1932 x 1932 pixels: 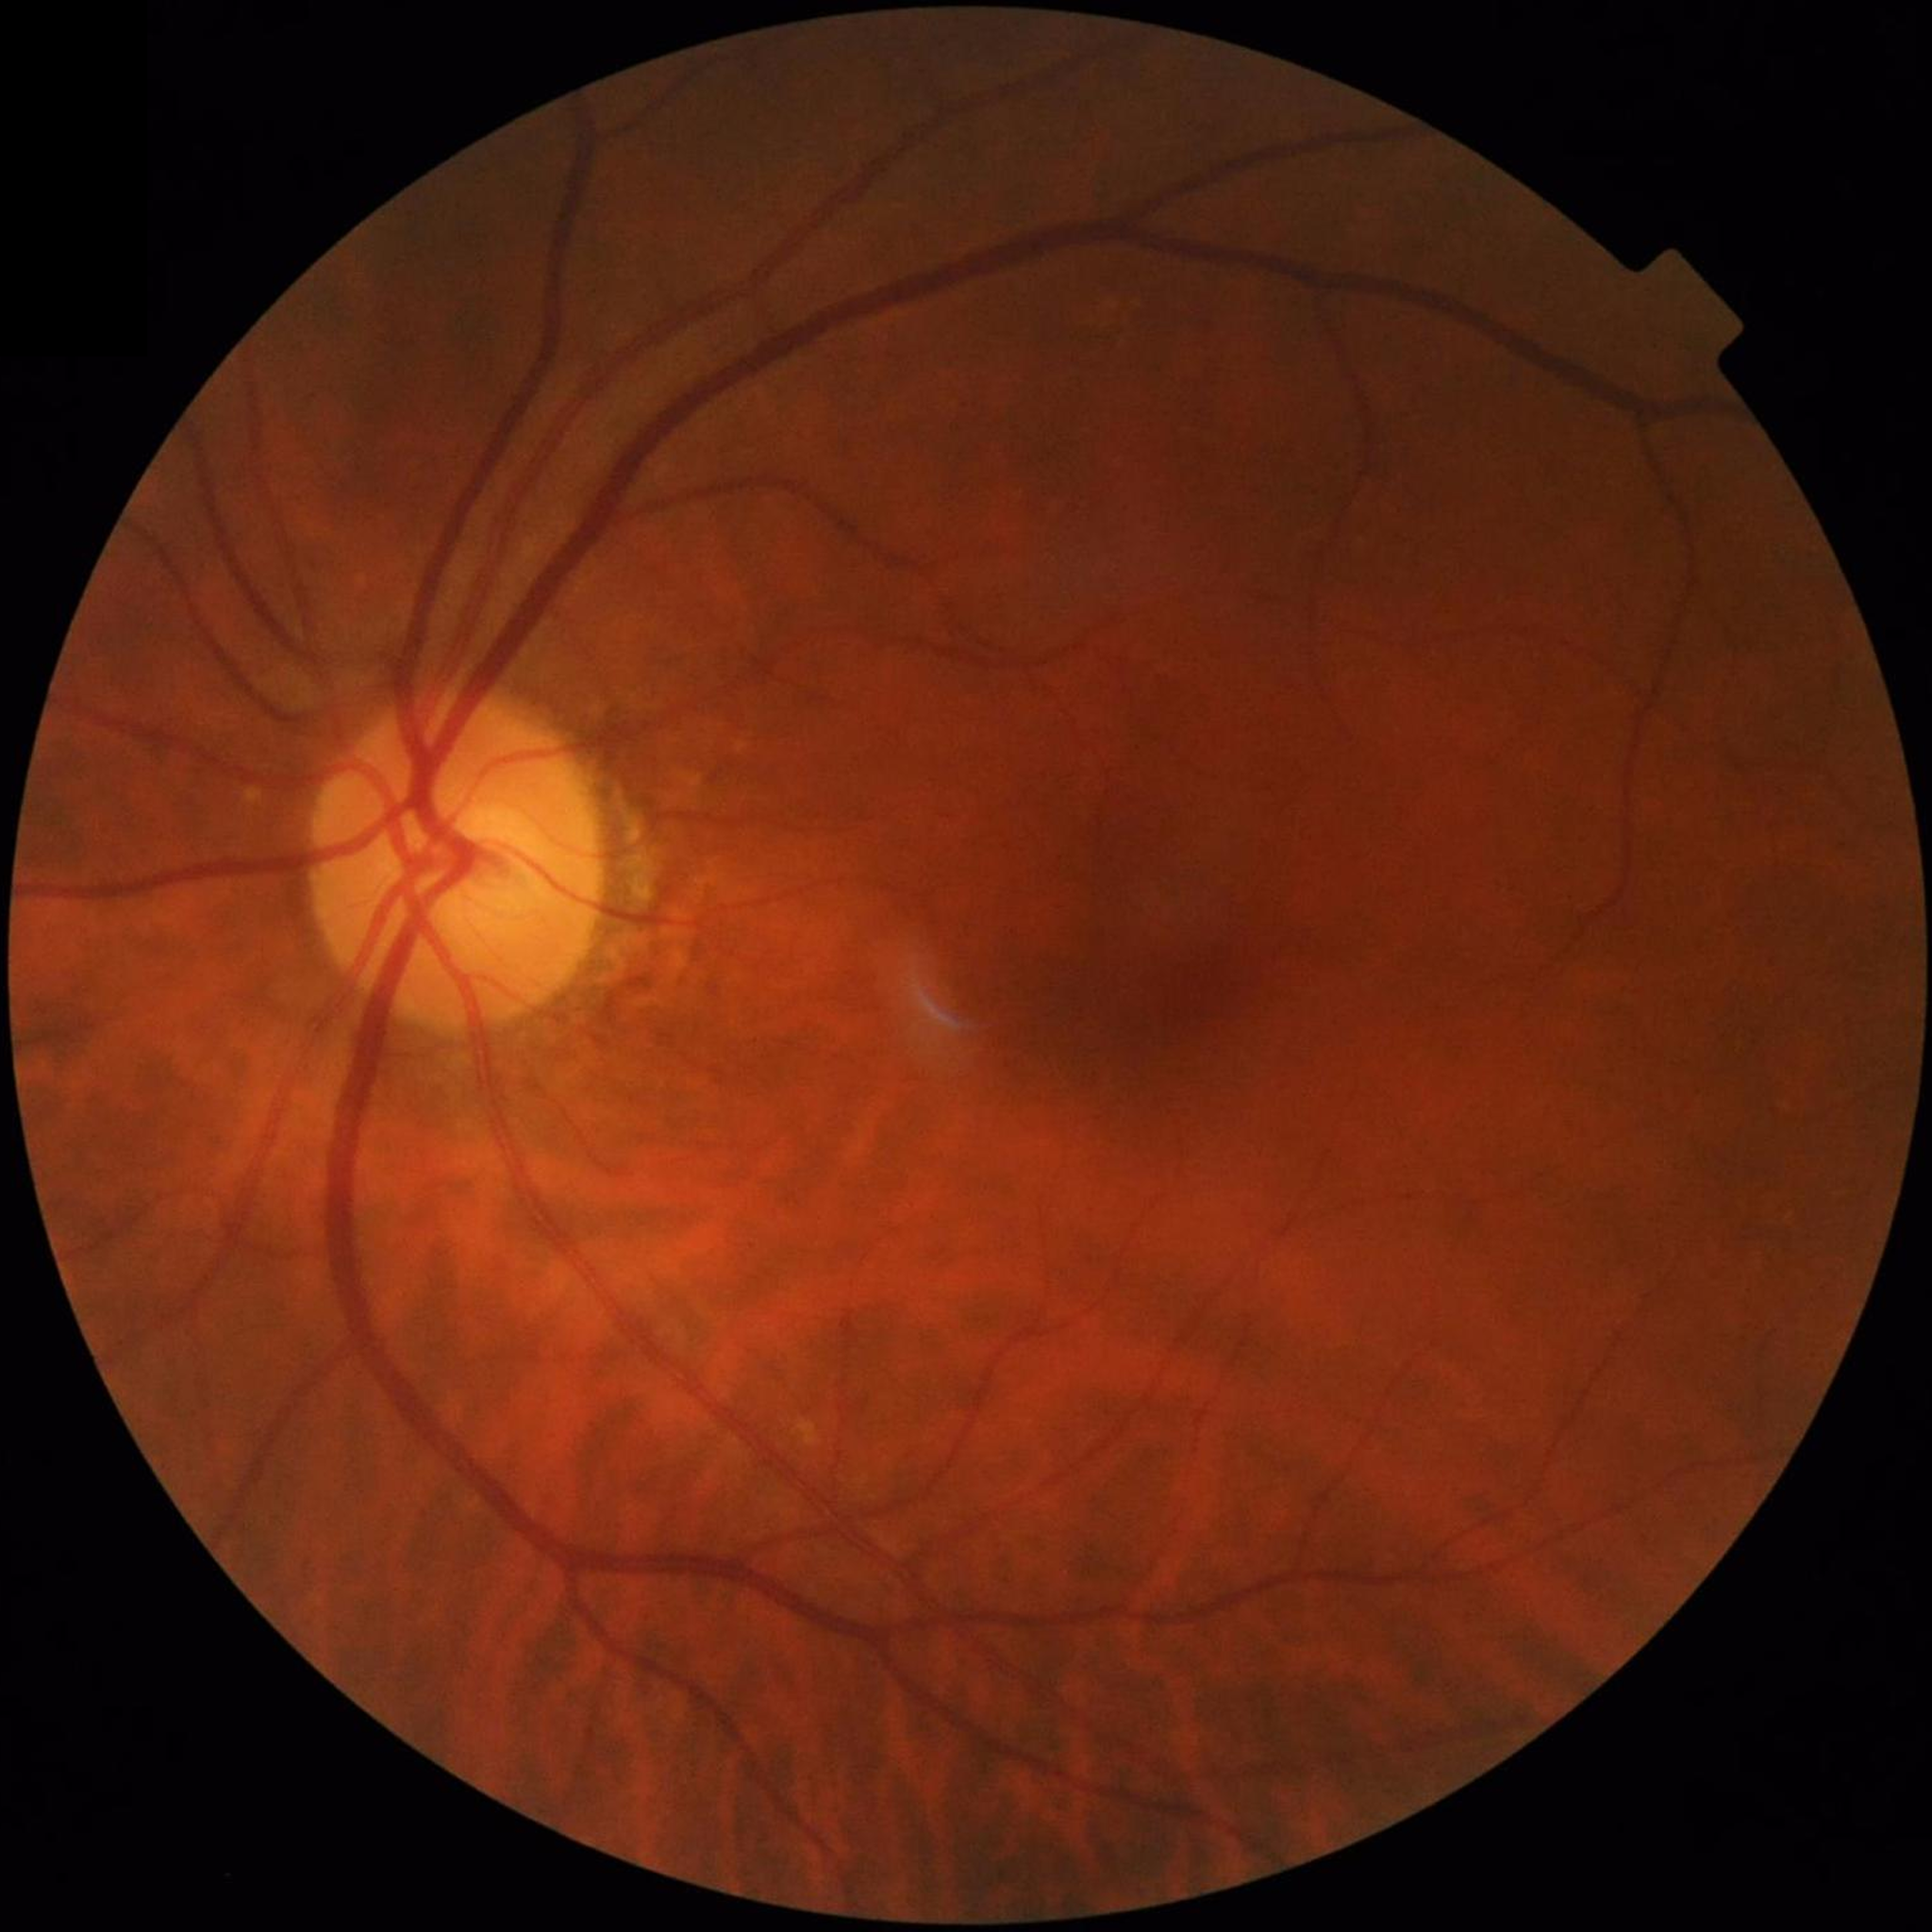

From a control without AMD, diabetic retinopathy, or glaucoma.